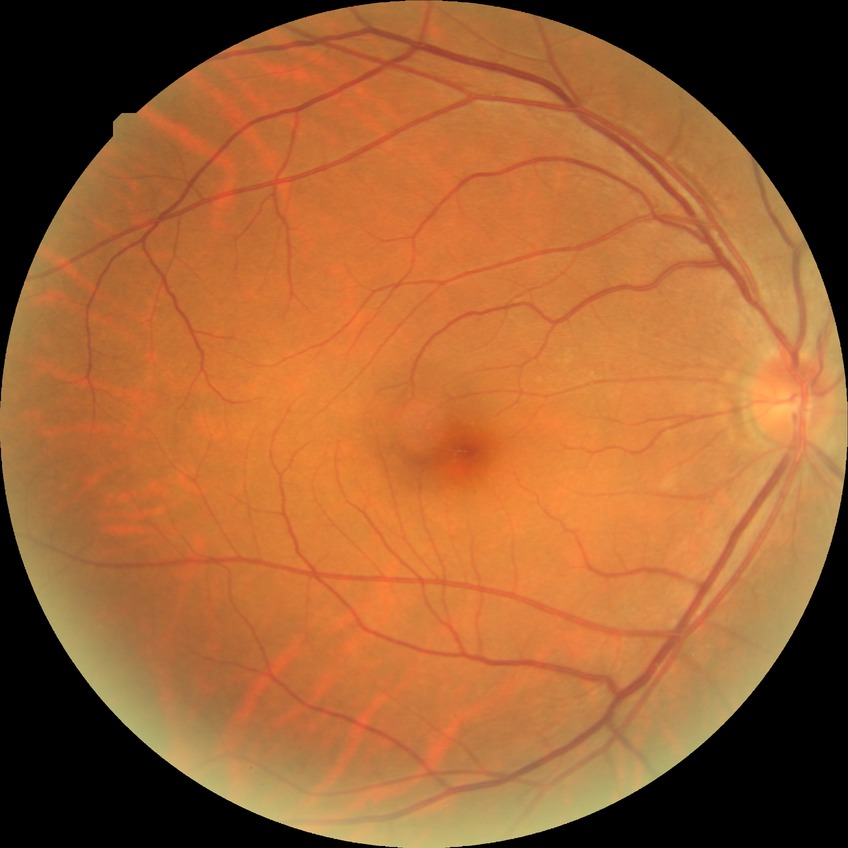
Diabetic retinopathy (DR) is NDR (no diabetic retinopathy).